1240x1240; infant wide-field retinal image; camera: Phoenix ICON (100° FOV):
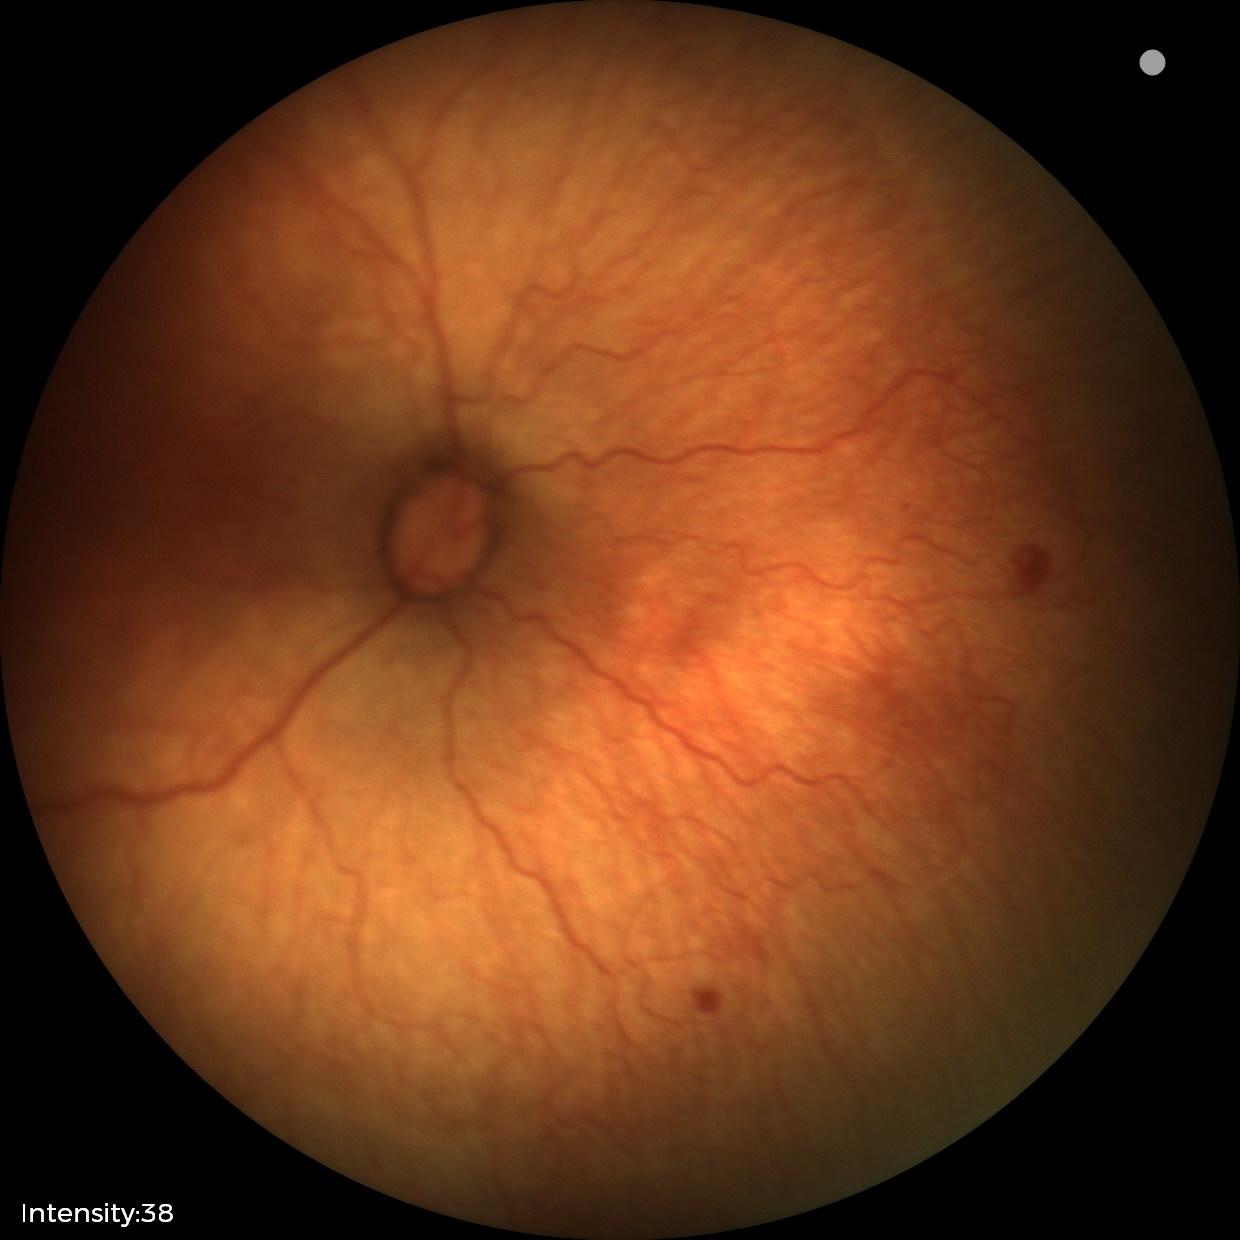 Impression: retinopathy of prematurity (ROP) stage 1.